Wide-field fundus photograph from neonatal ROP screening: 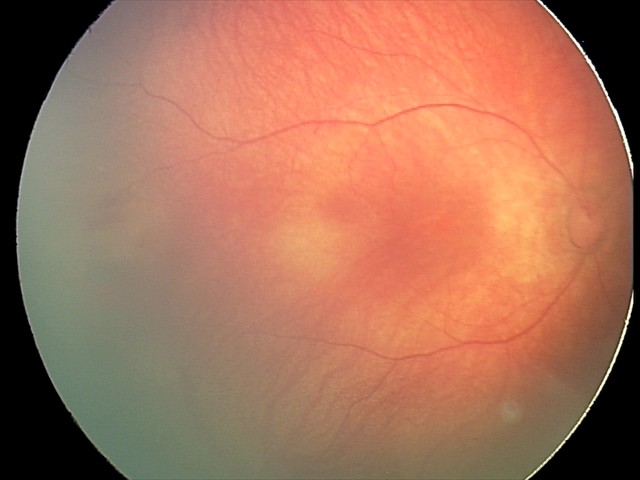 Screening: retinal hemorrhages.